2352x1568px: 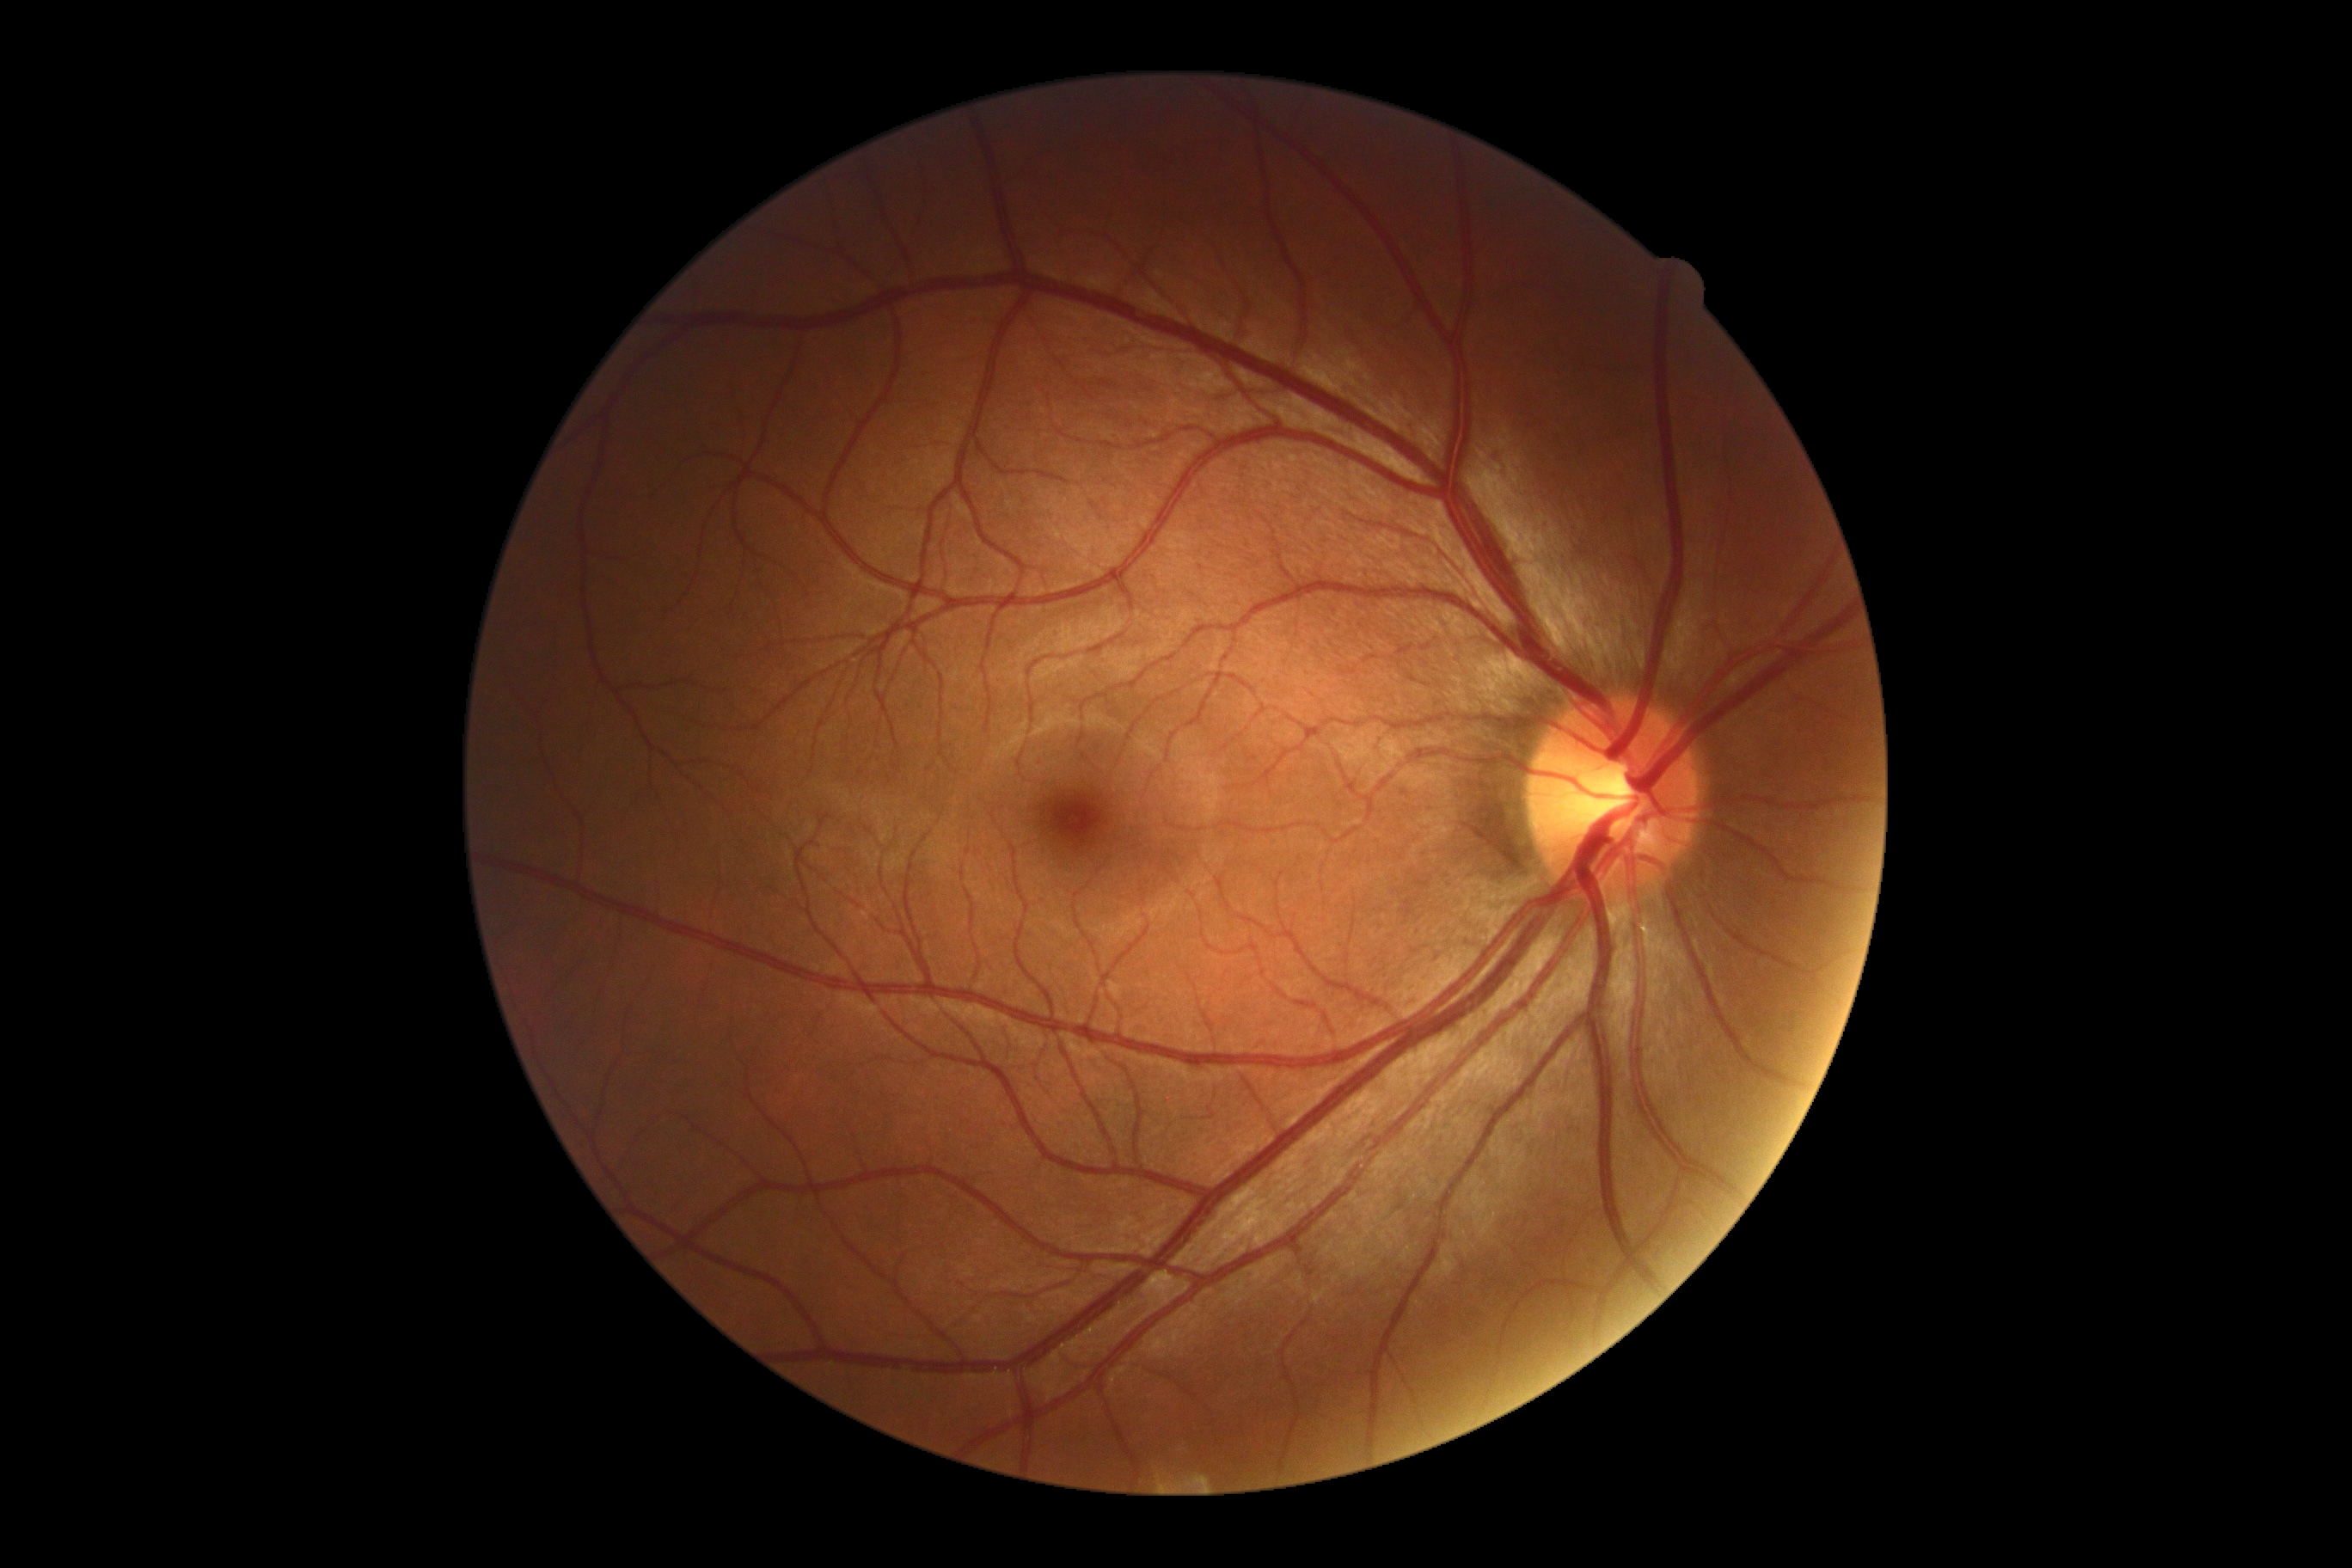

• DR impression: no apparent DR
• retinopathy: grade 0 (no apparent retinopathy)